Color fundus photograph, 240 x 240 pixels: 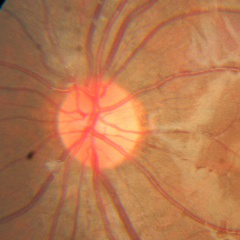
Glaucoma assessment: no glaucomatous findings.